45° field of view:
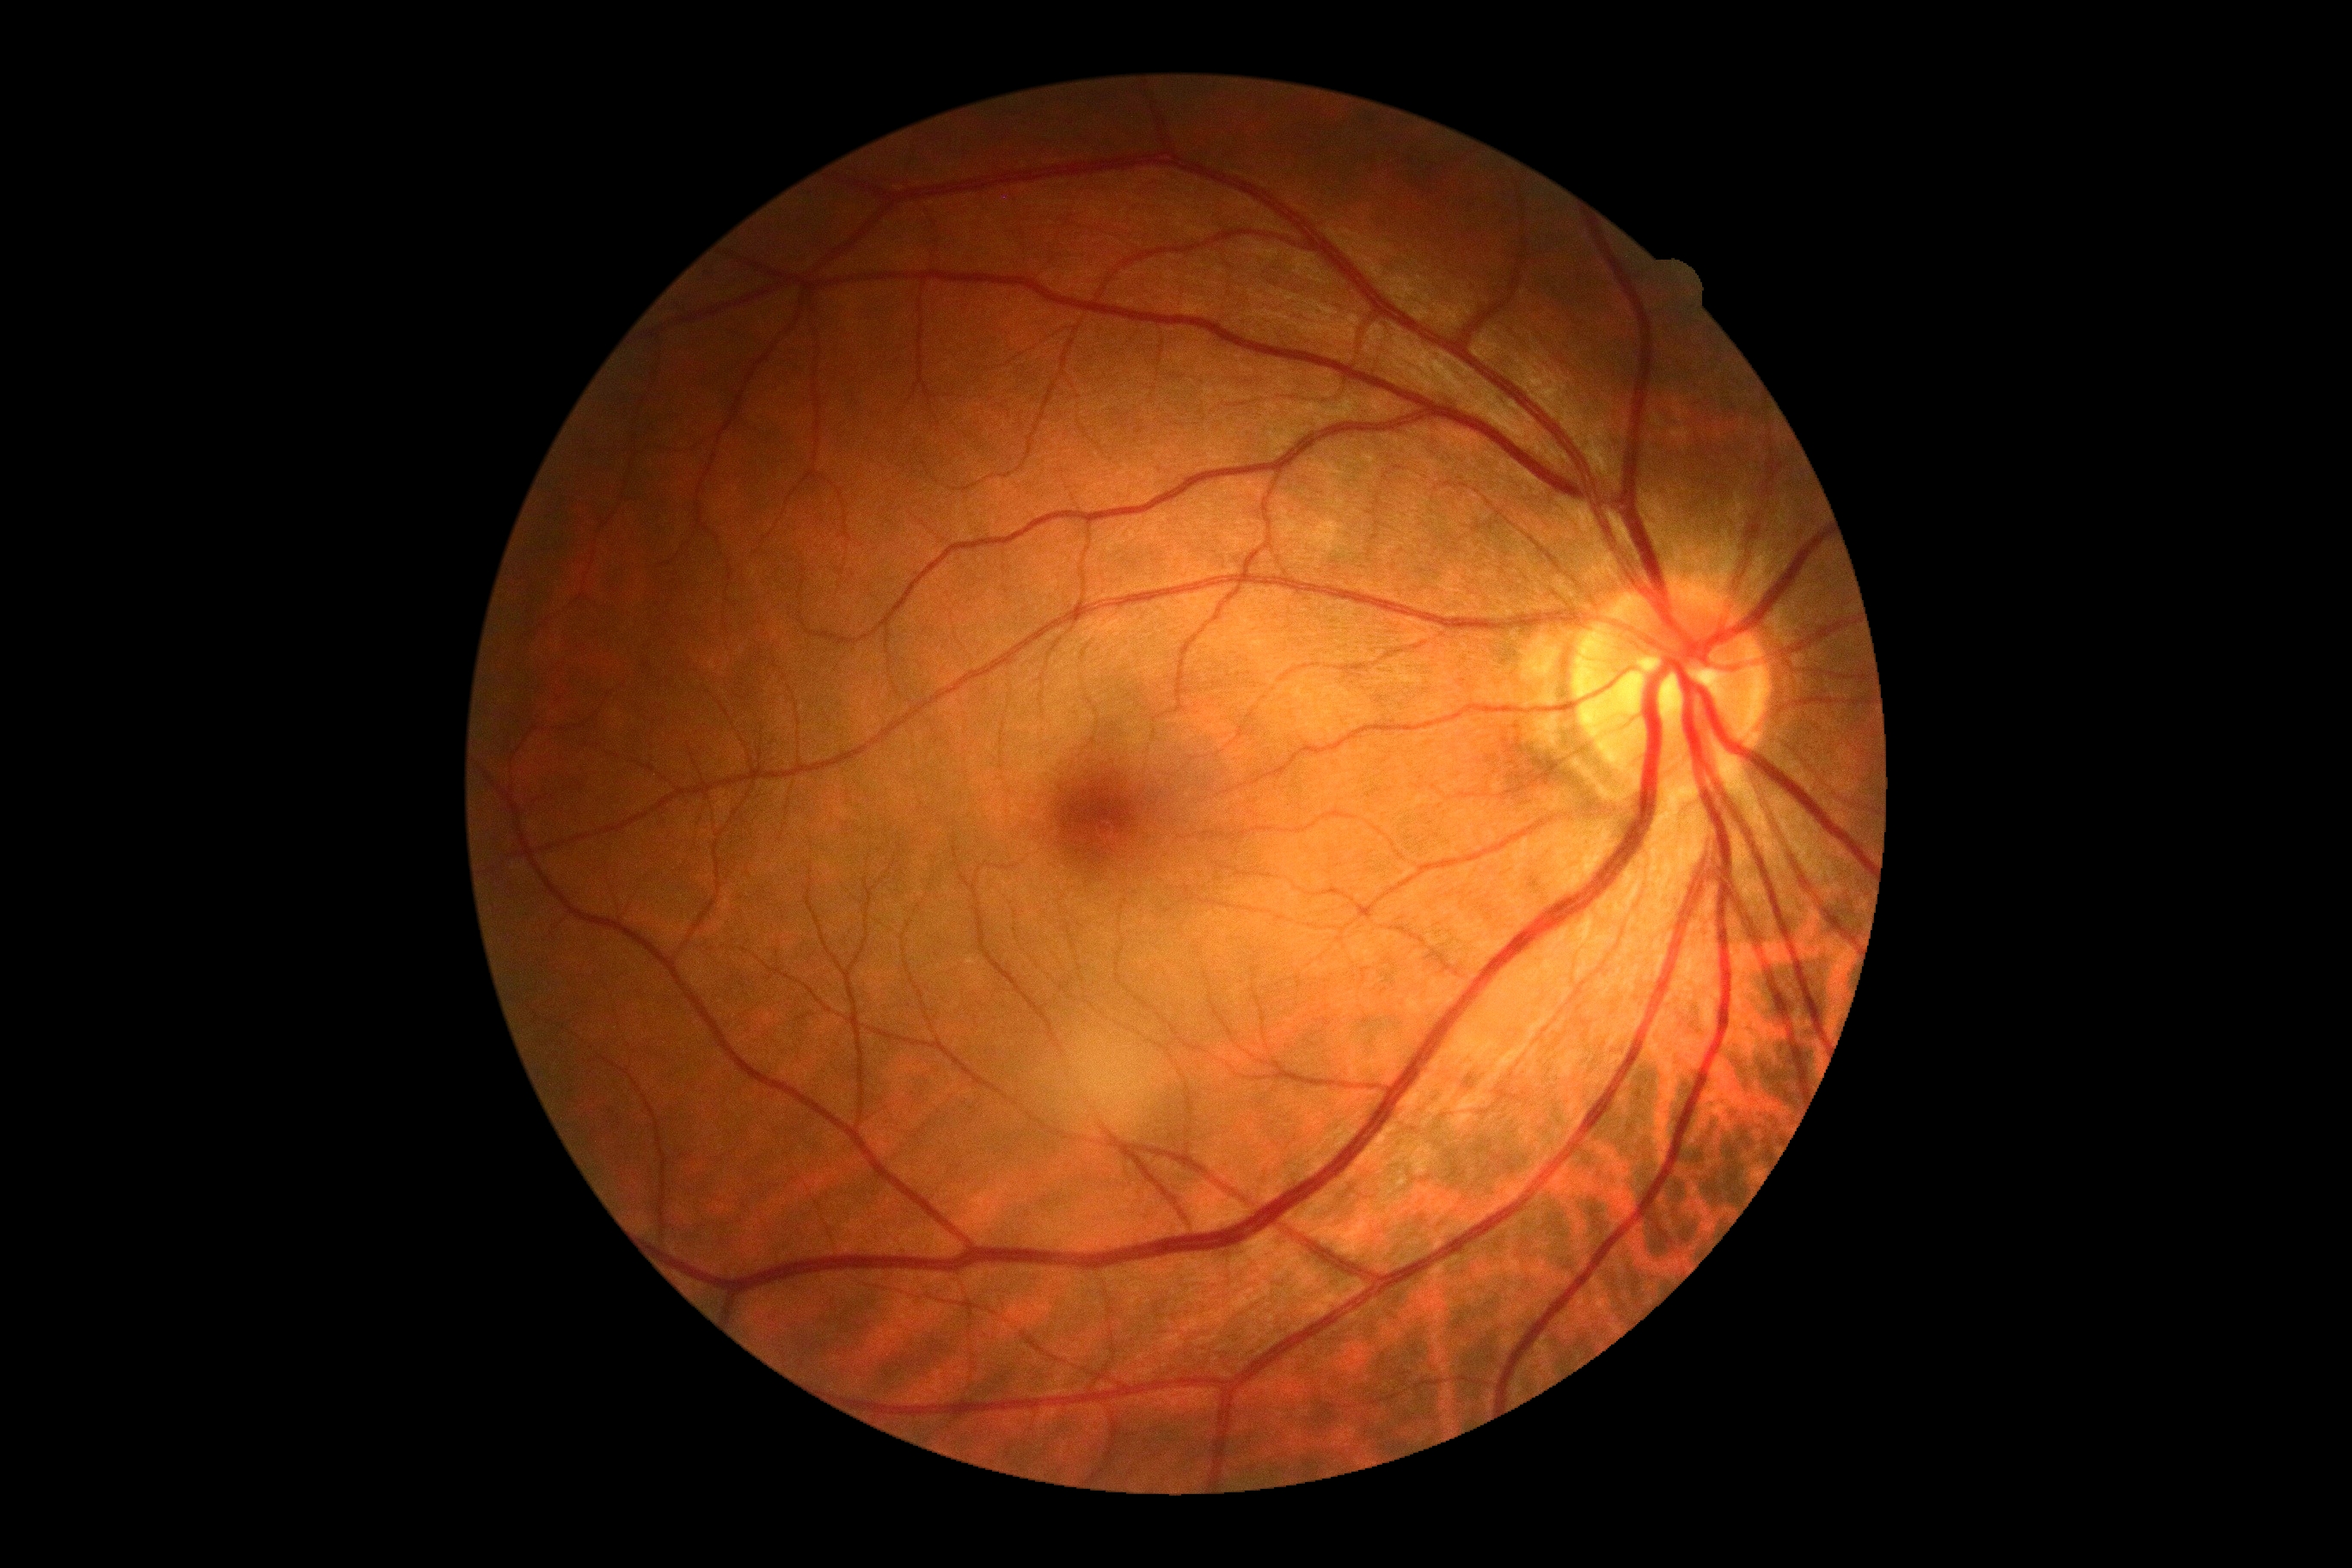 Findings:
* DR — no apparent diabetic retinopathy (grade 0)